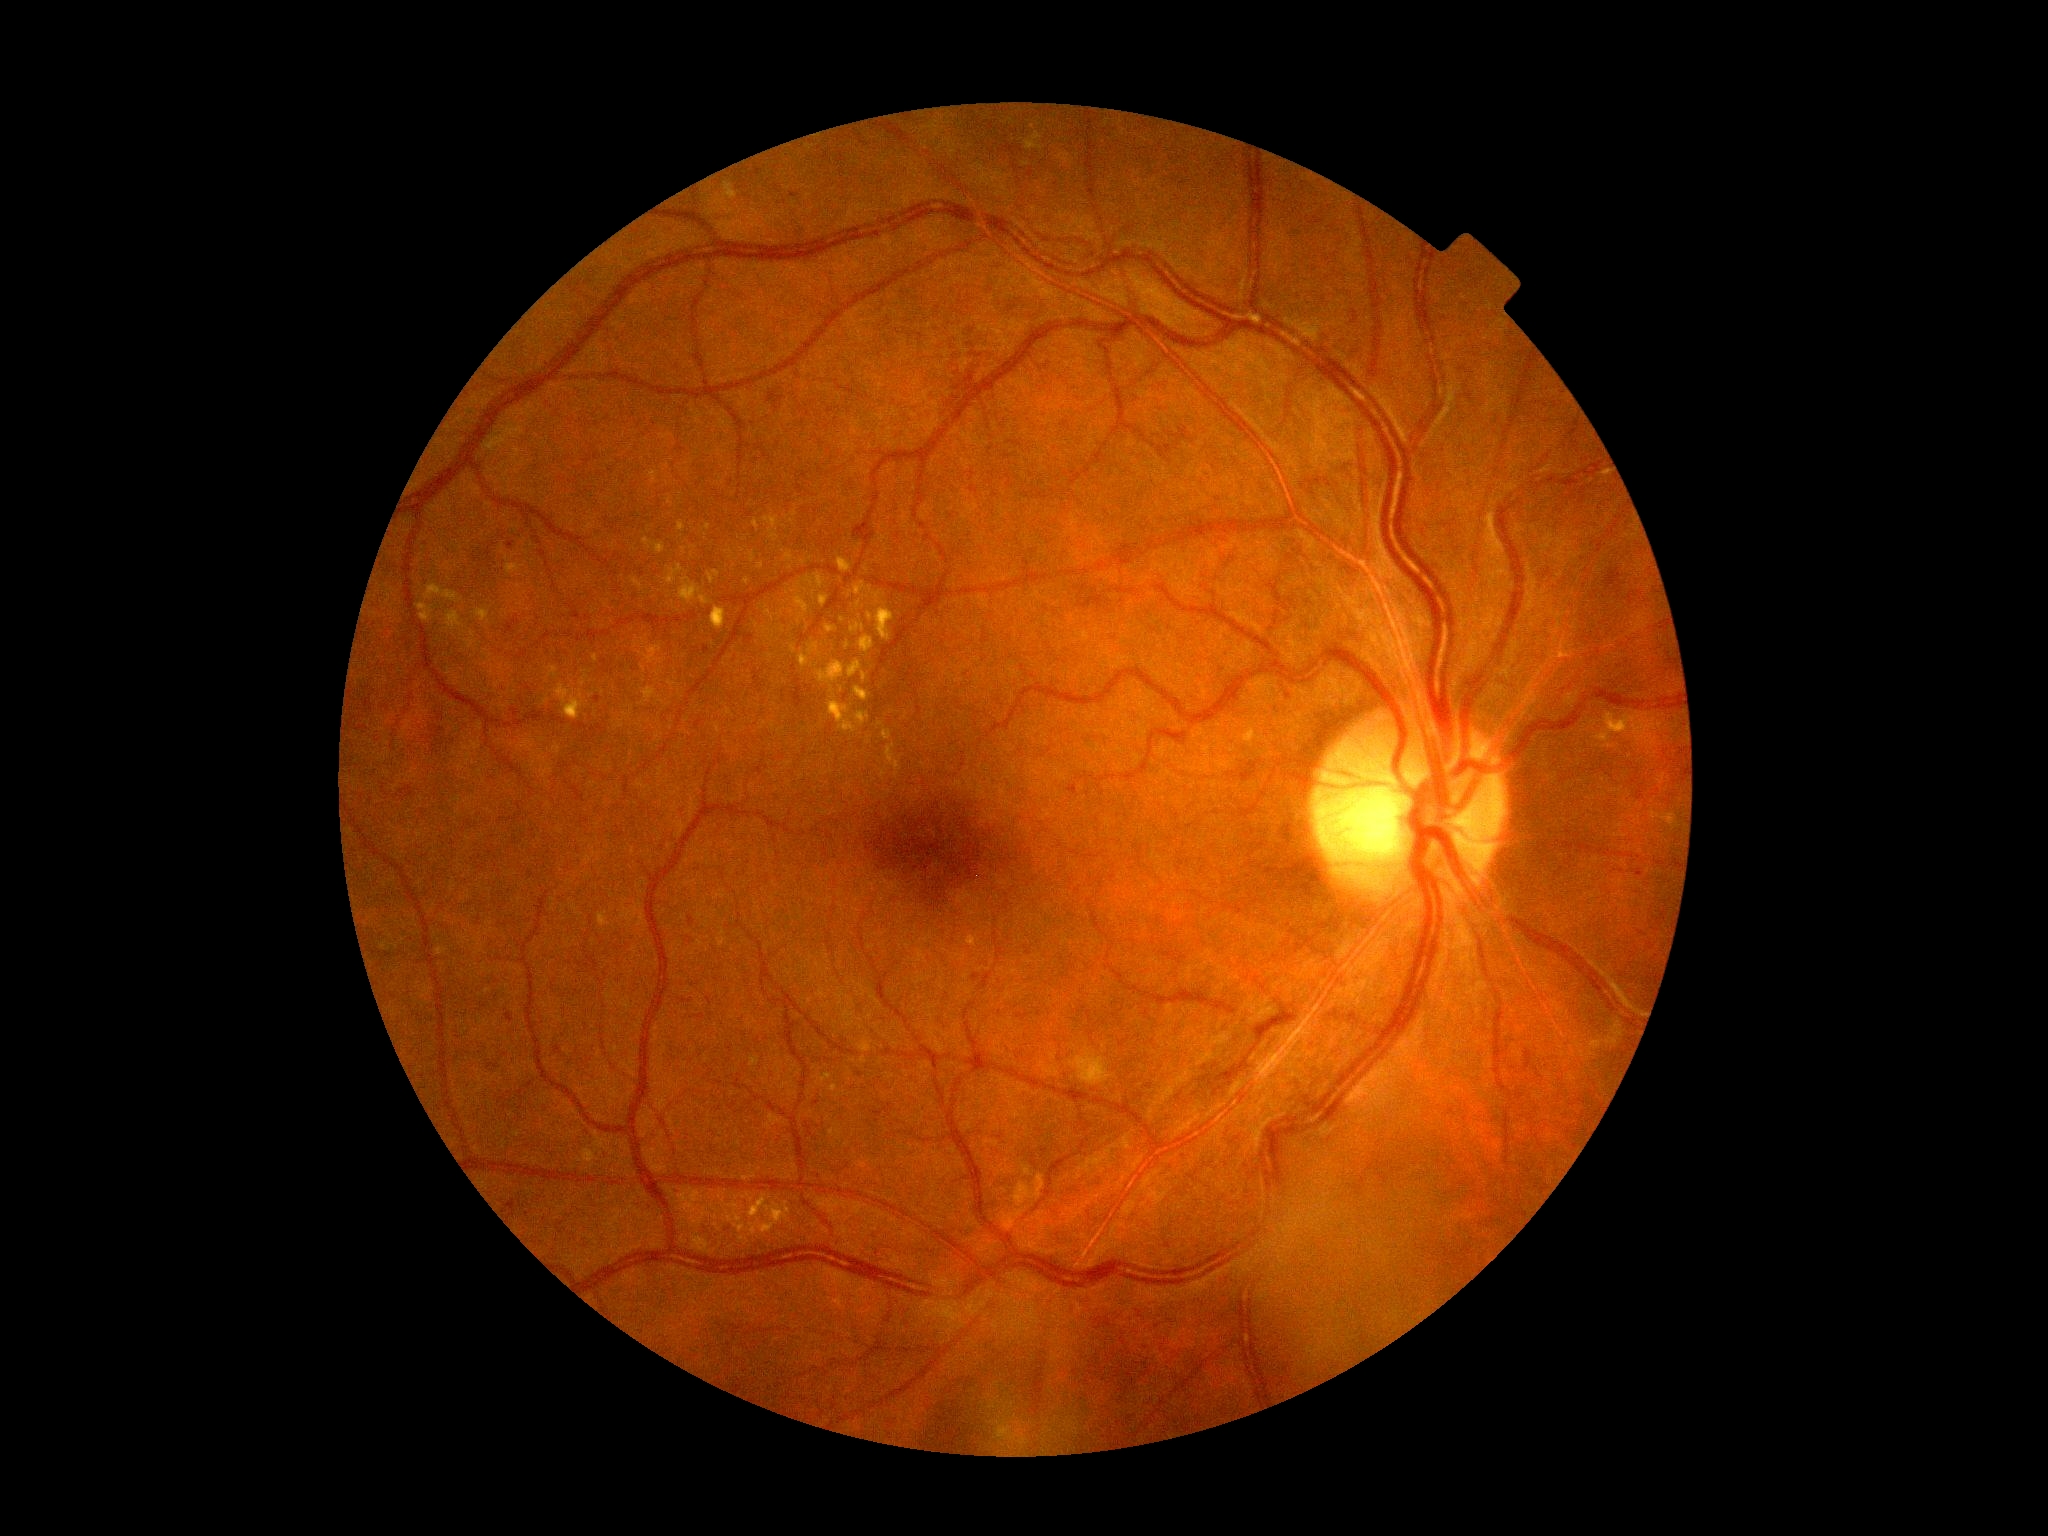 Diabetic retinopathy severity: moderate NPDR (grade 2).